Captured with the Phoenix ICON (100° field of view); image size 1240x1240; Phoenix ICON wide-field infant fundus image:
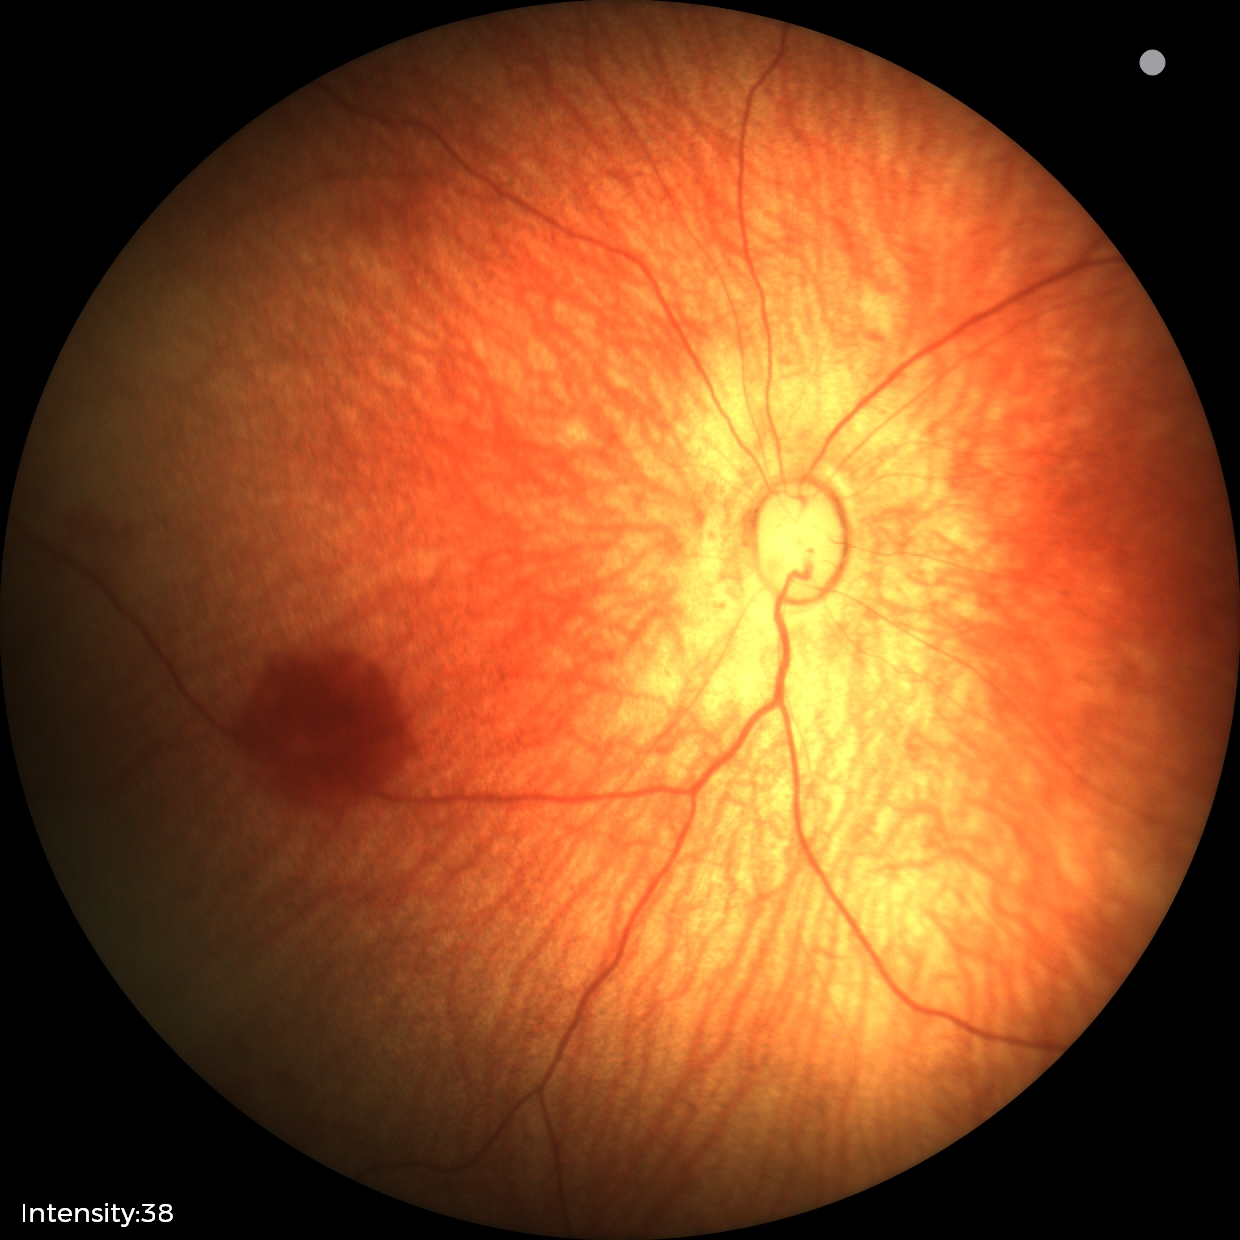

Normal screening examination.